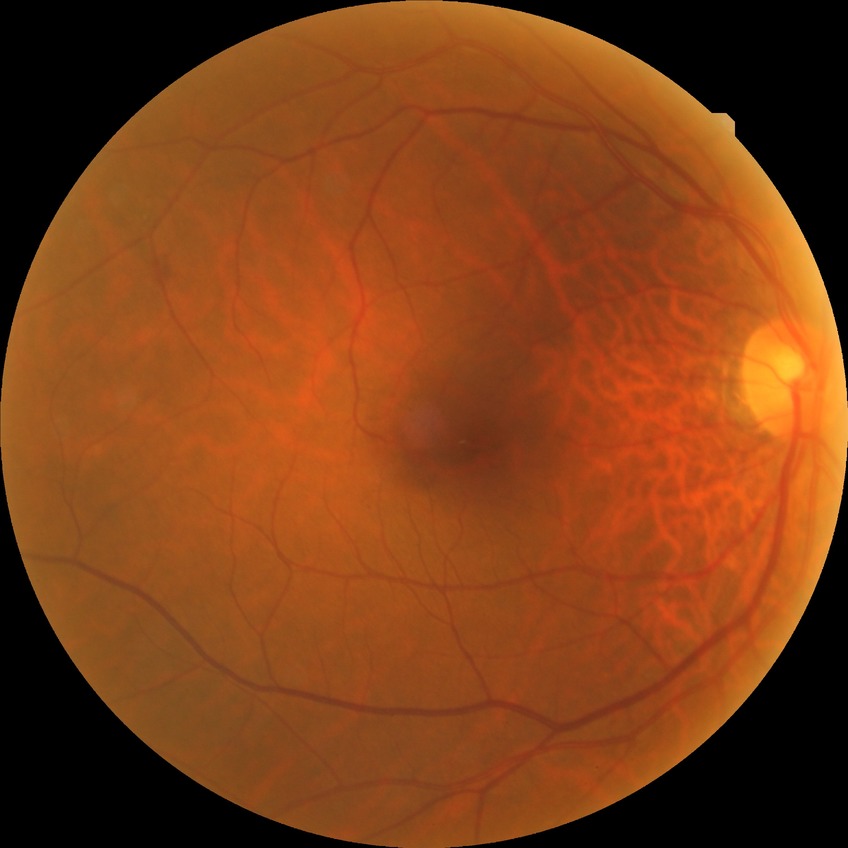 Diabetic retinopathy (DR): NDR (no diabetic retinopathy).